45° field of view, 2212 by 1659 pixels:
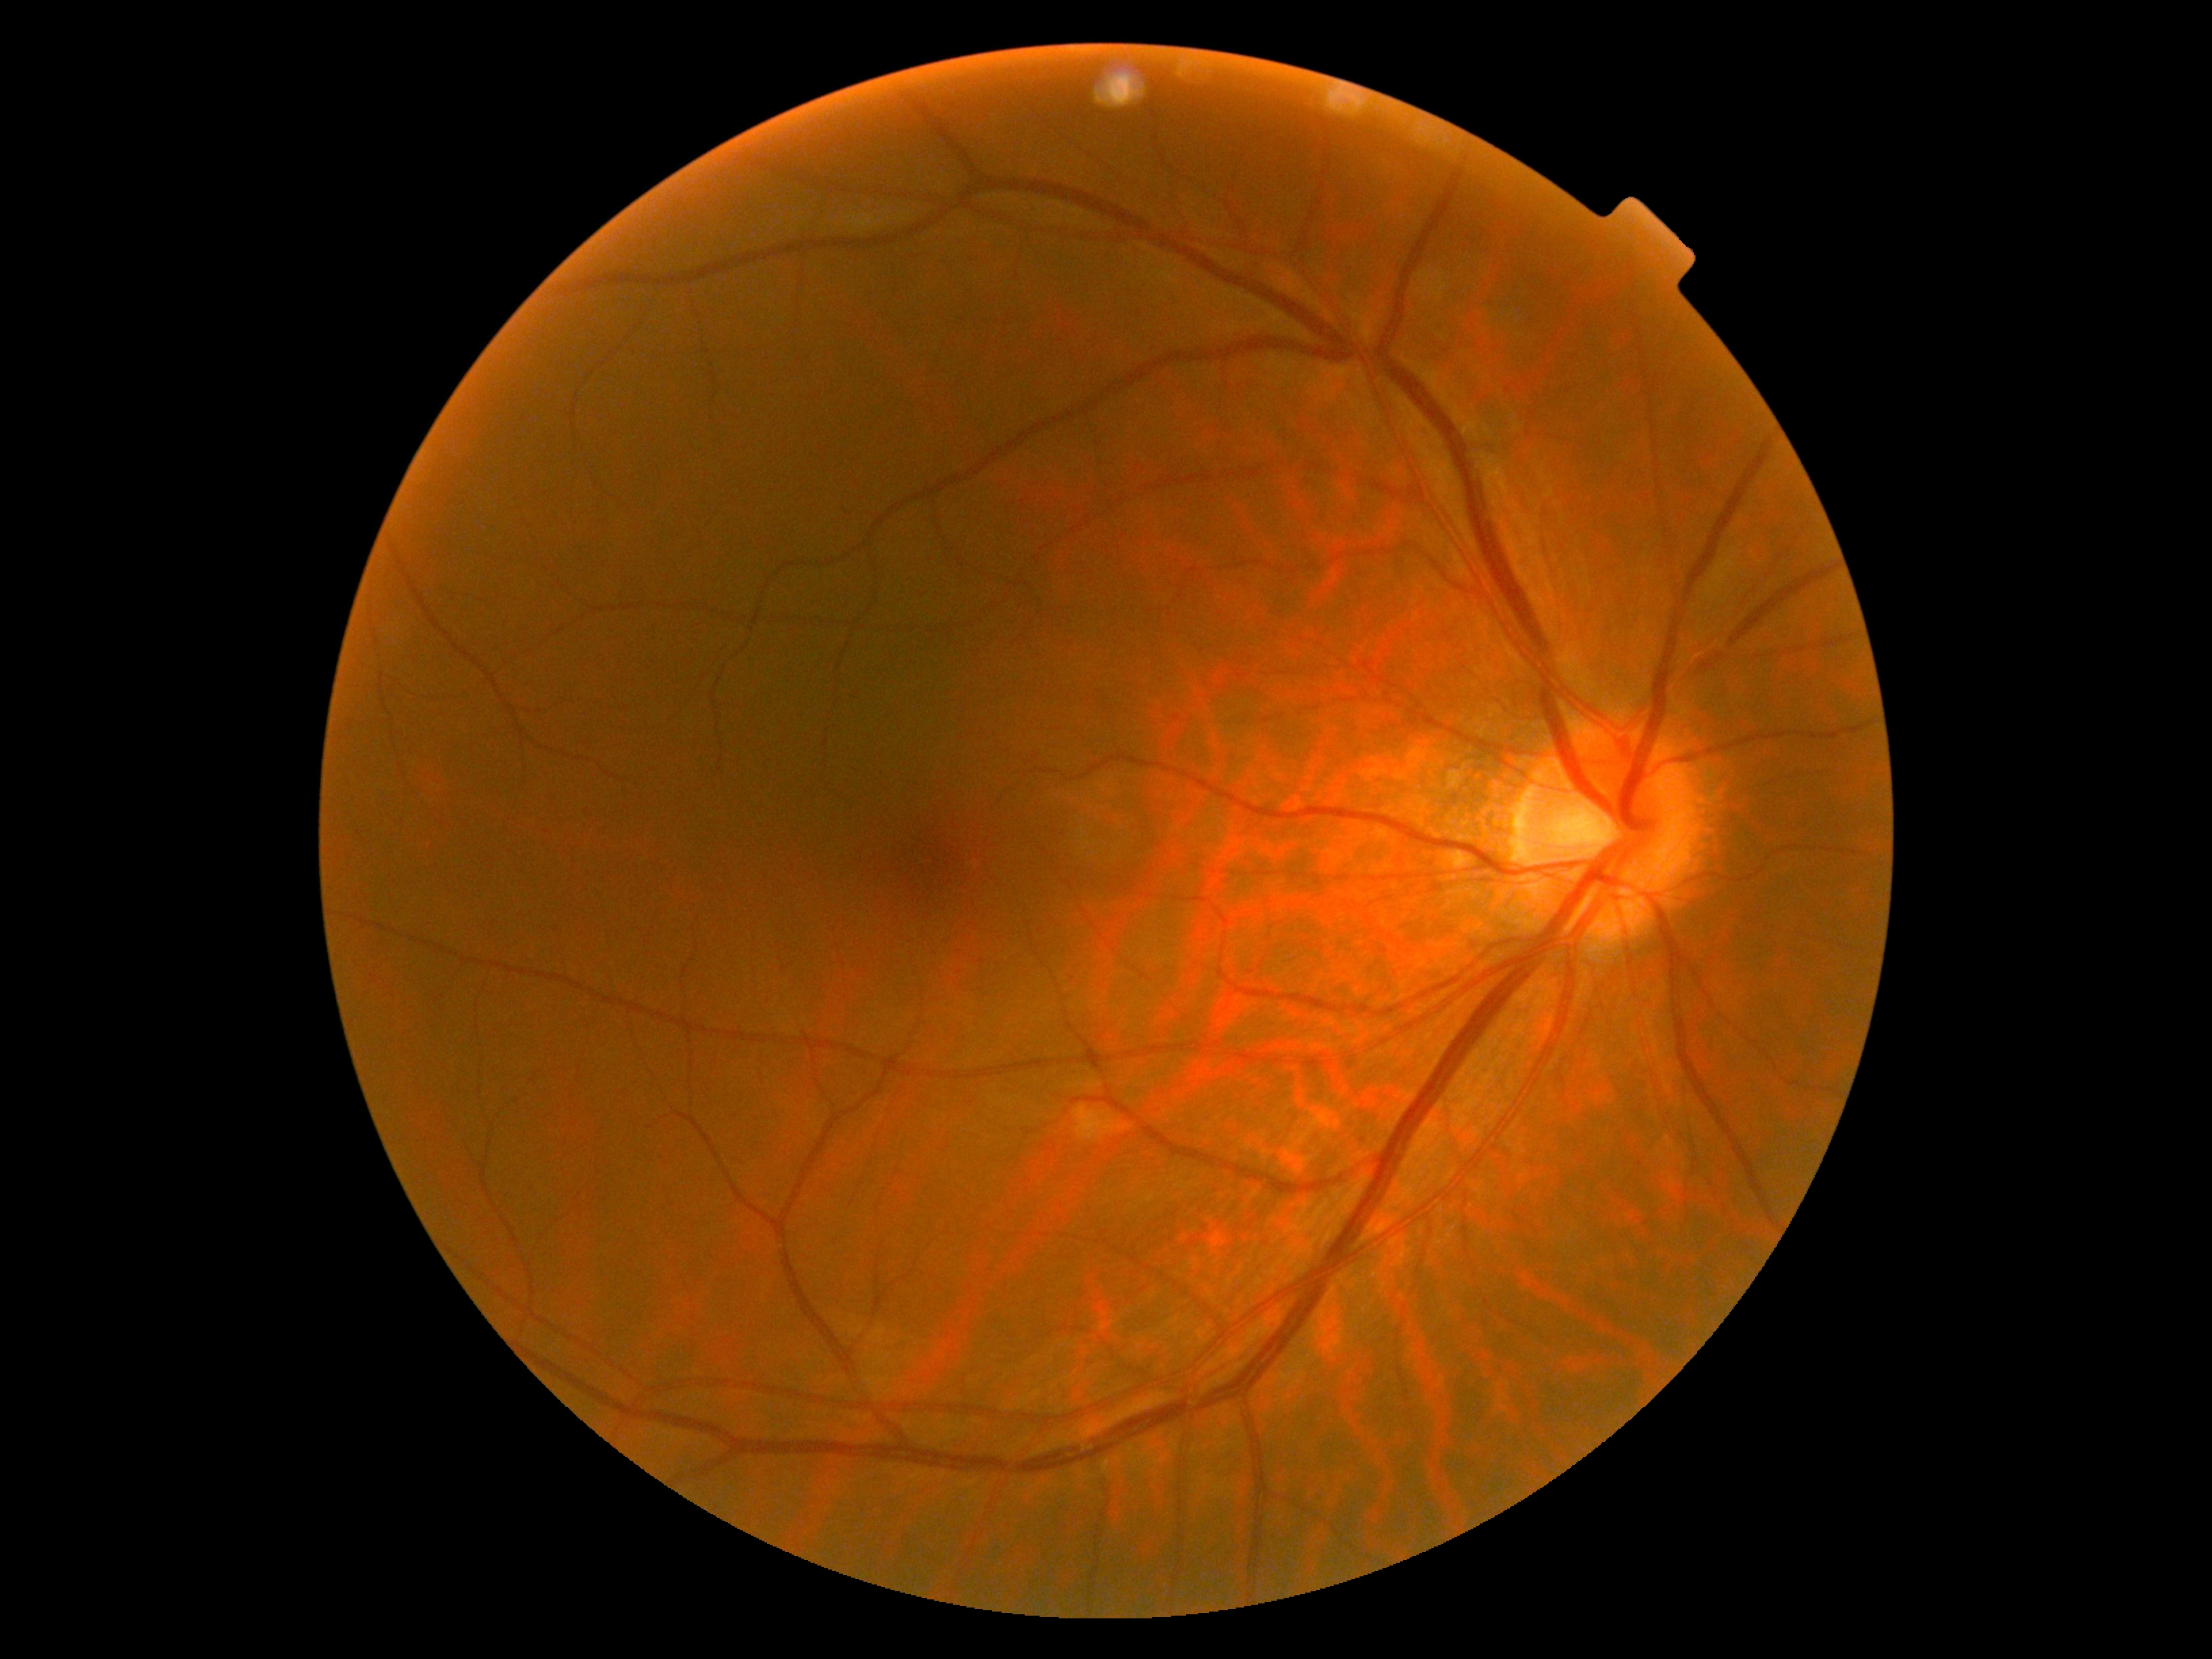 No DR findings.
Diabetic retinopathy is no apparent diabetic retinopathy (grade 0).